Nonmydriatic fundus photograph; NIDEK AFC-230 fundus camera
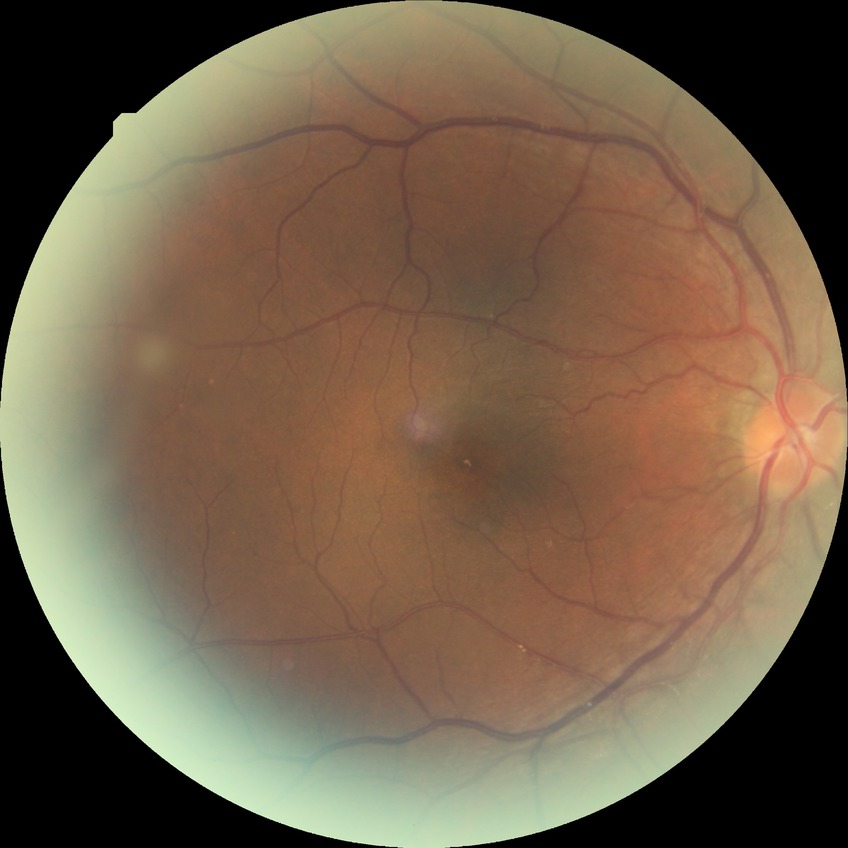 diabetic retinopathy (DR) = no diabetic retinopathy (NDR).